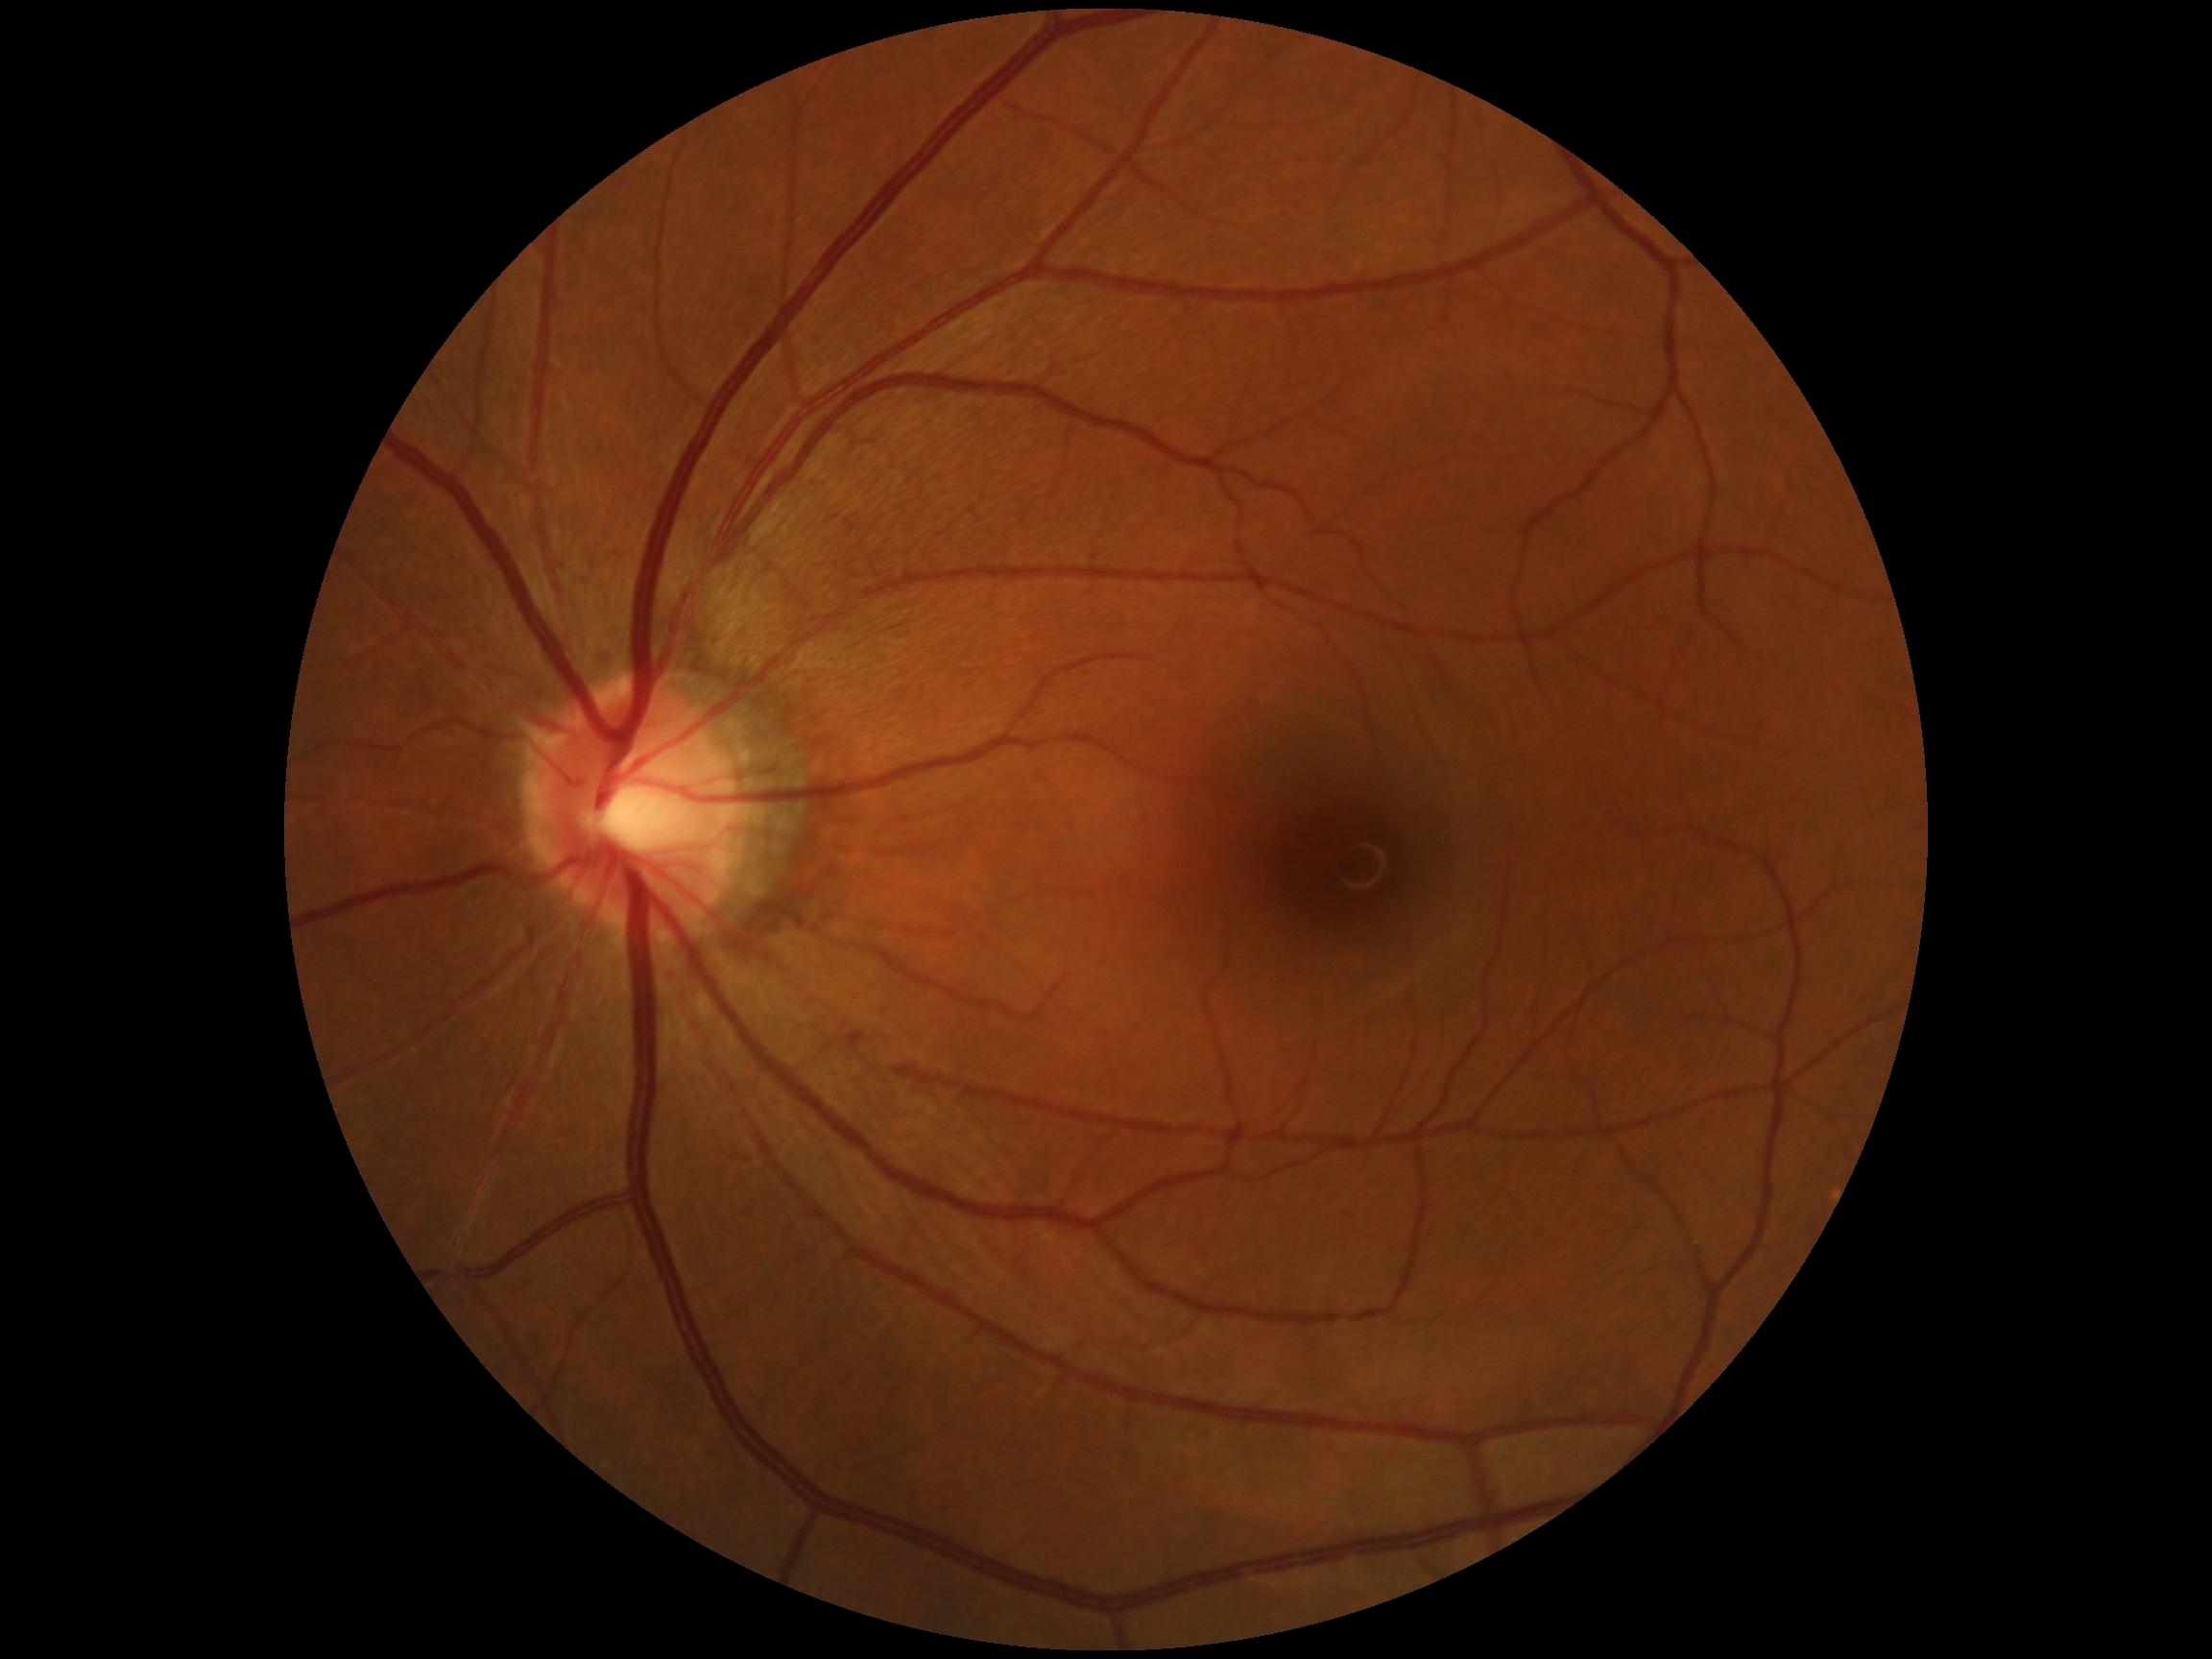

No apparent diabetic retinopathy.
Retinopathy: 0 — no visible signs of diabetic retinopathy.